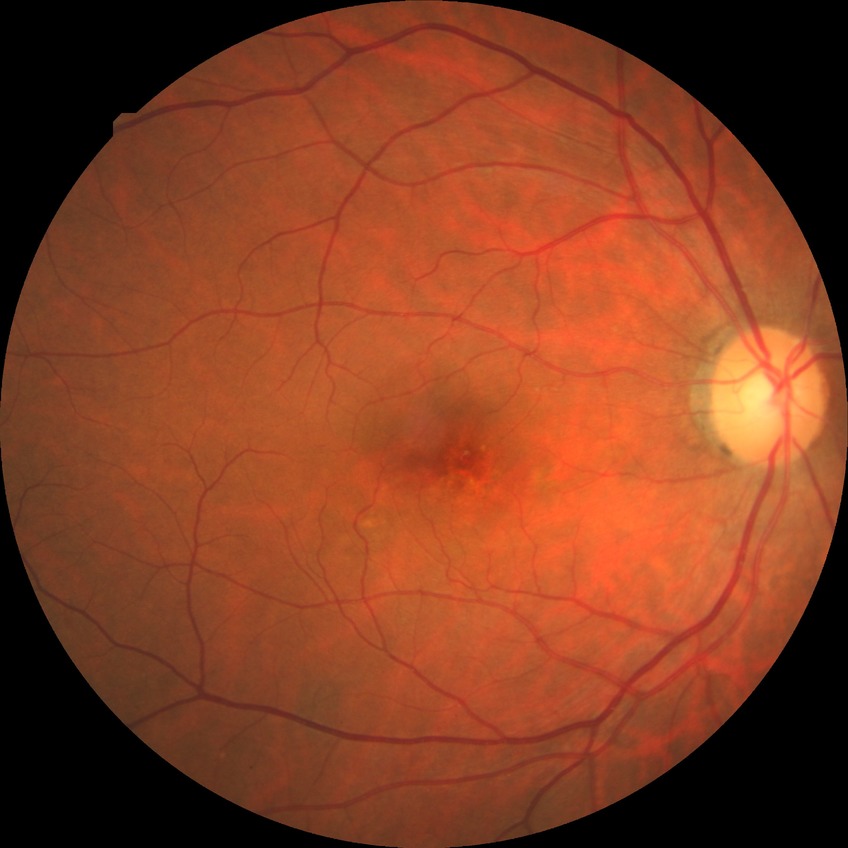 modified Davis grading: no diabetic retinopathy